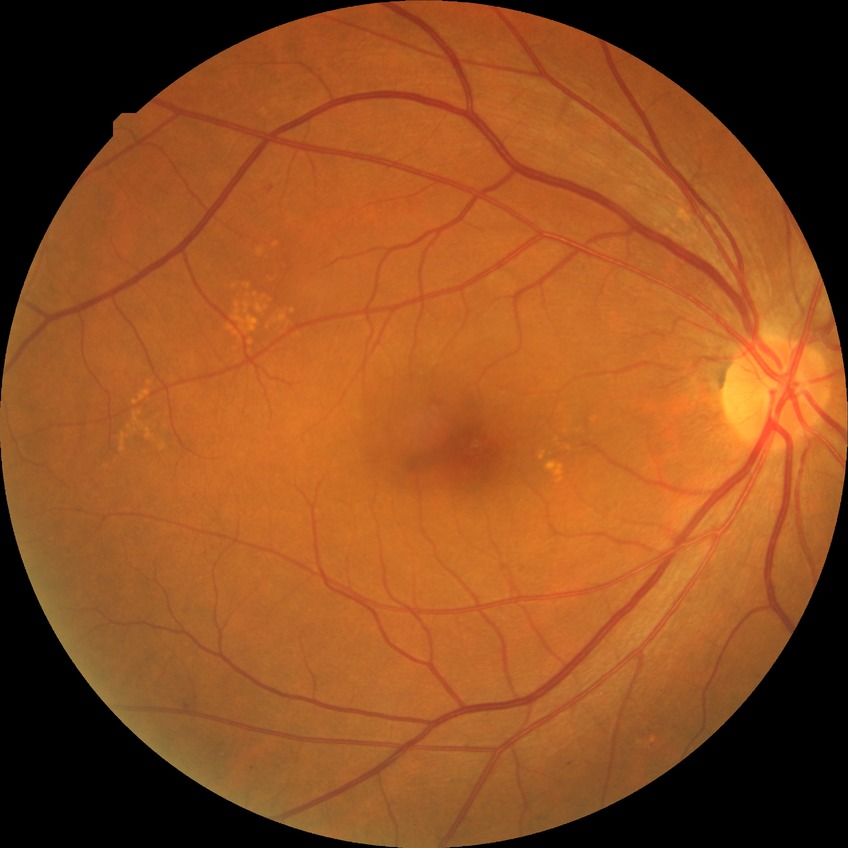   davis_grade: simple diabetic retinopathy (SDR)